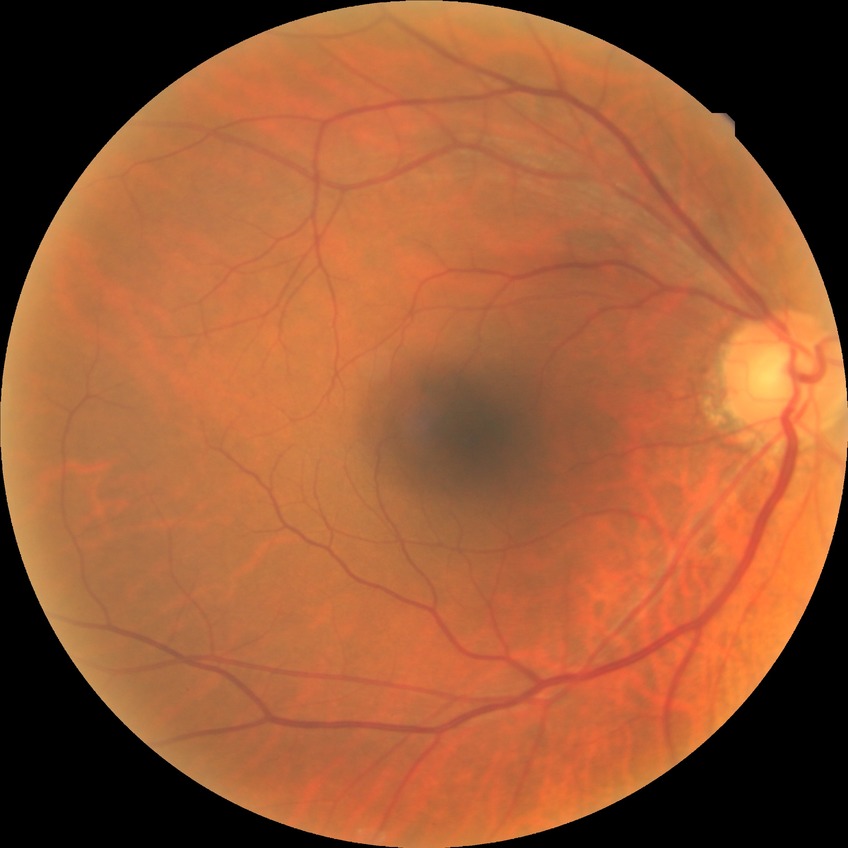
Modified Davis grade: NDR.